Captured on a Nidek AFC-330 fundus camera — 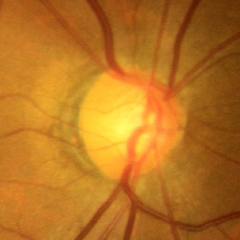

Glaucoma is present. Fundus image with findings of early glaucomatous optic neuropathy.